Modified Davis classification; nonmydriatic; 848x848px; 45° FOV: 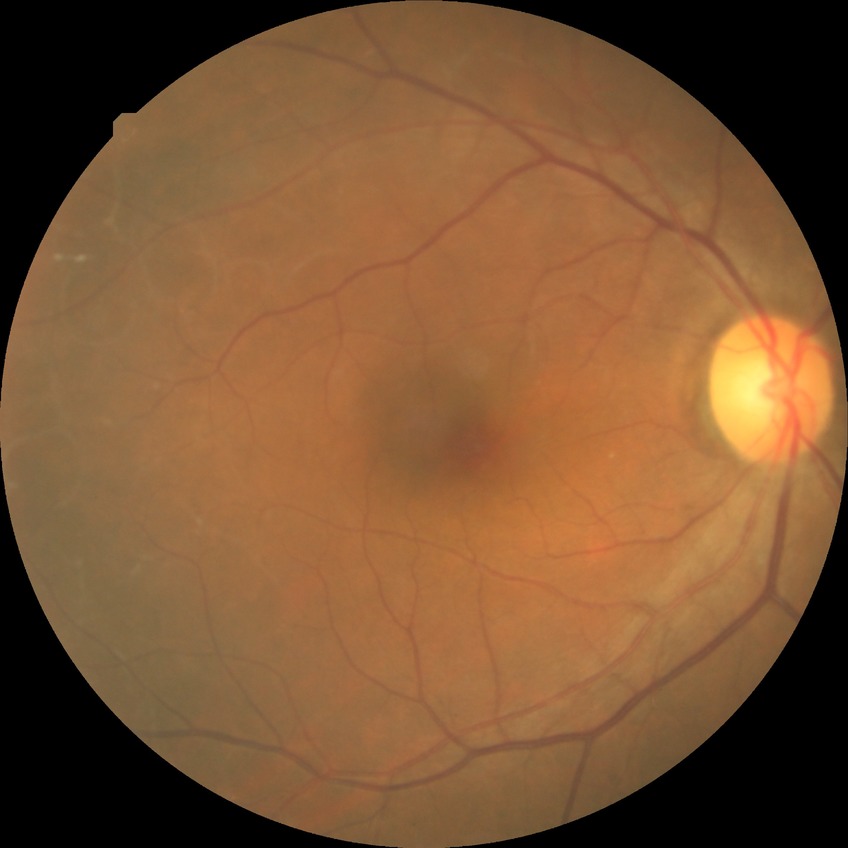
Modified Davis grading is no diabetic retinopathy.